Color fundus image · nonmydriatic fundus photograph · diabetic retinopathy graded by the modified Davis classification.
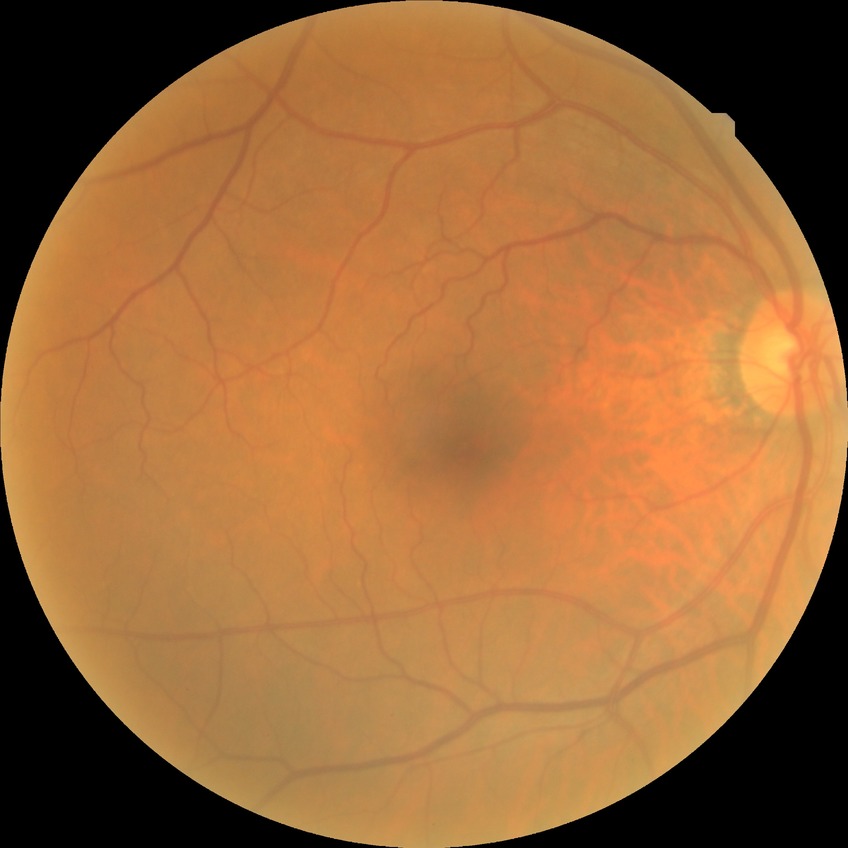

Modified Davis classification is no diabetic retinopathy.